Posterior pole color fundus photograph. Nonmydriatic fundus photograph — 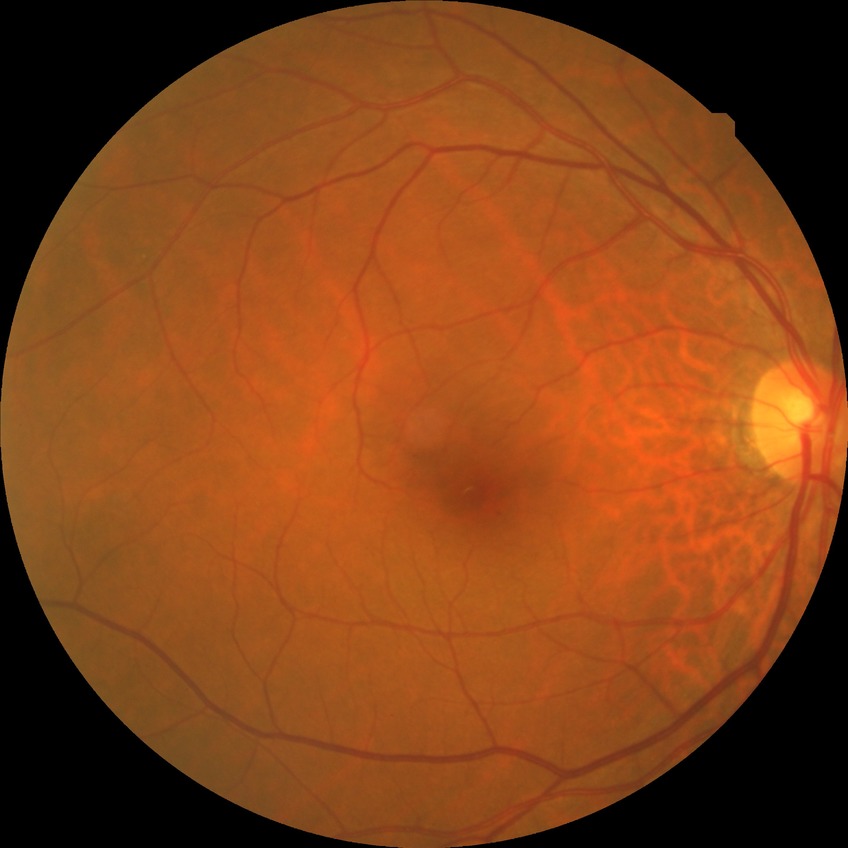
DR class: non-proliferative diabetic retinopathy. Modified Davis classification is simple diabetic retinopathy.